Image size 1240x1240; wide-field fundus photograph from neonatal ROP screening.
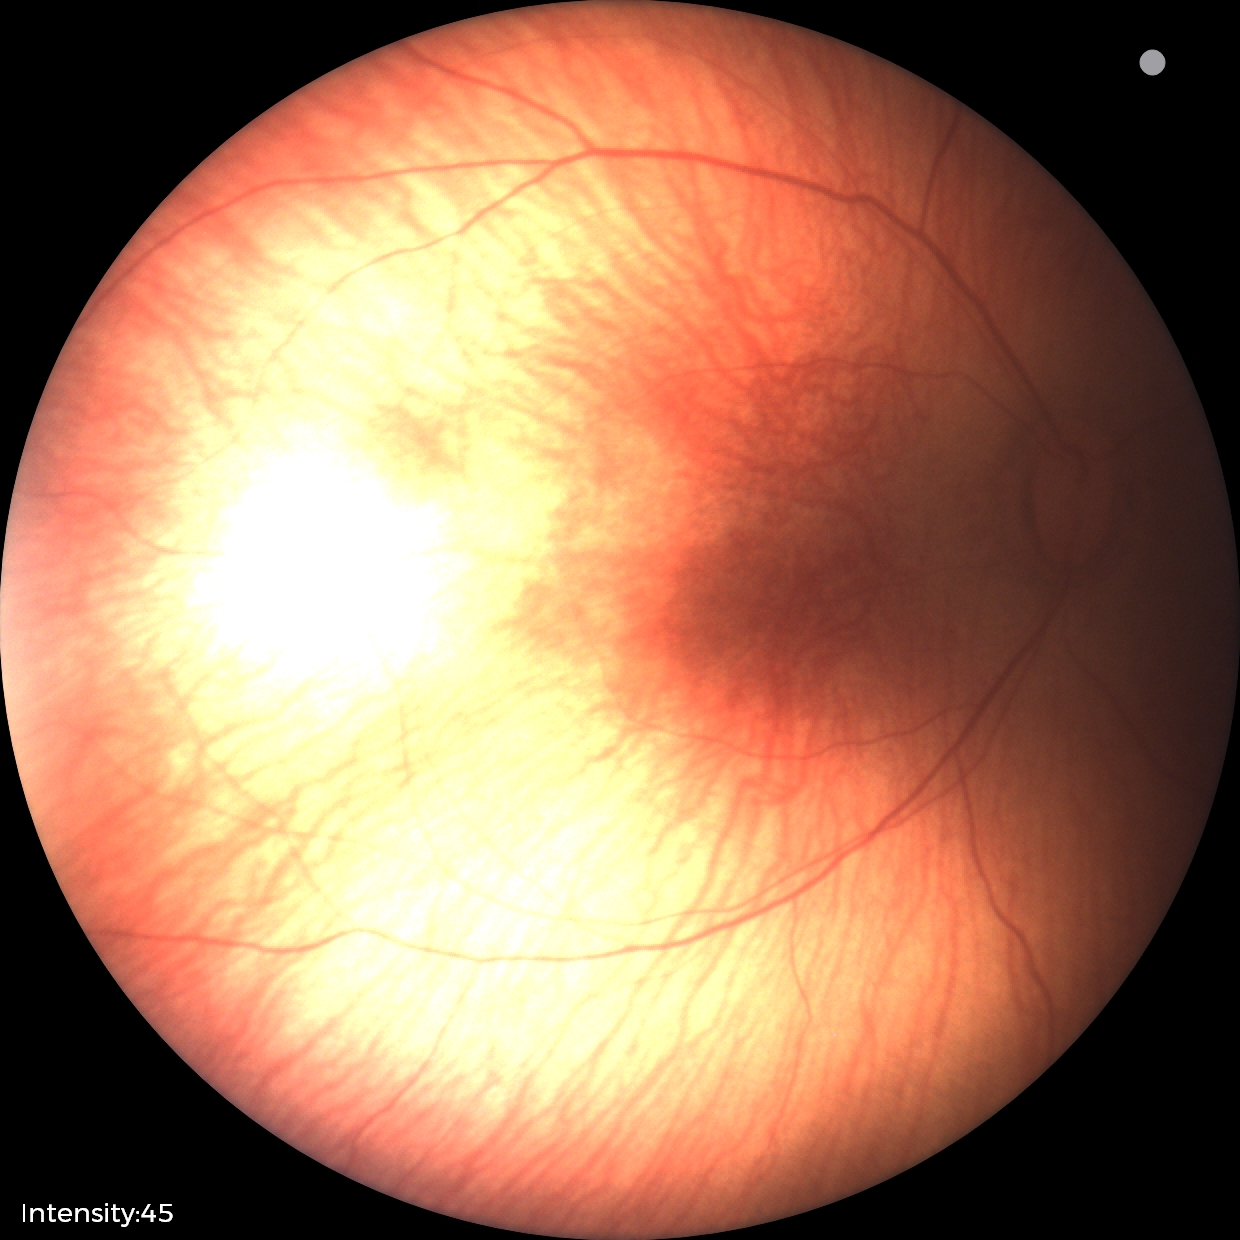 No plus disease. Screening examination consistent with ROP stage 2.